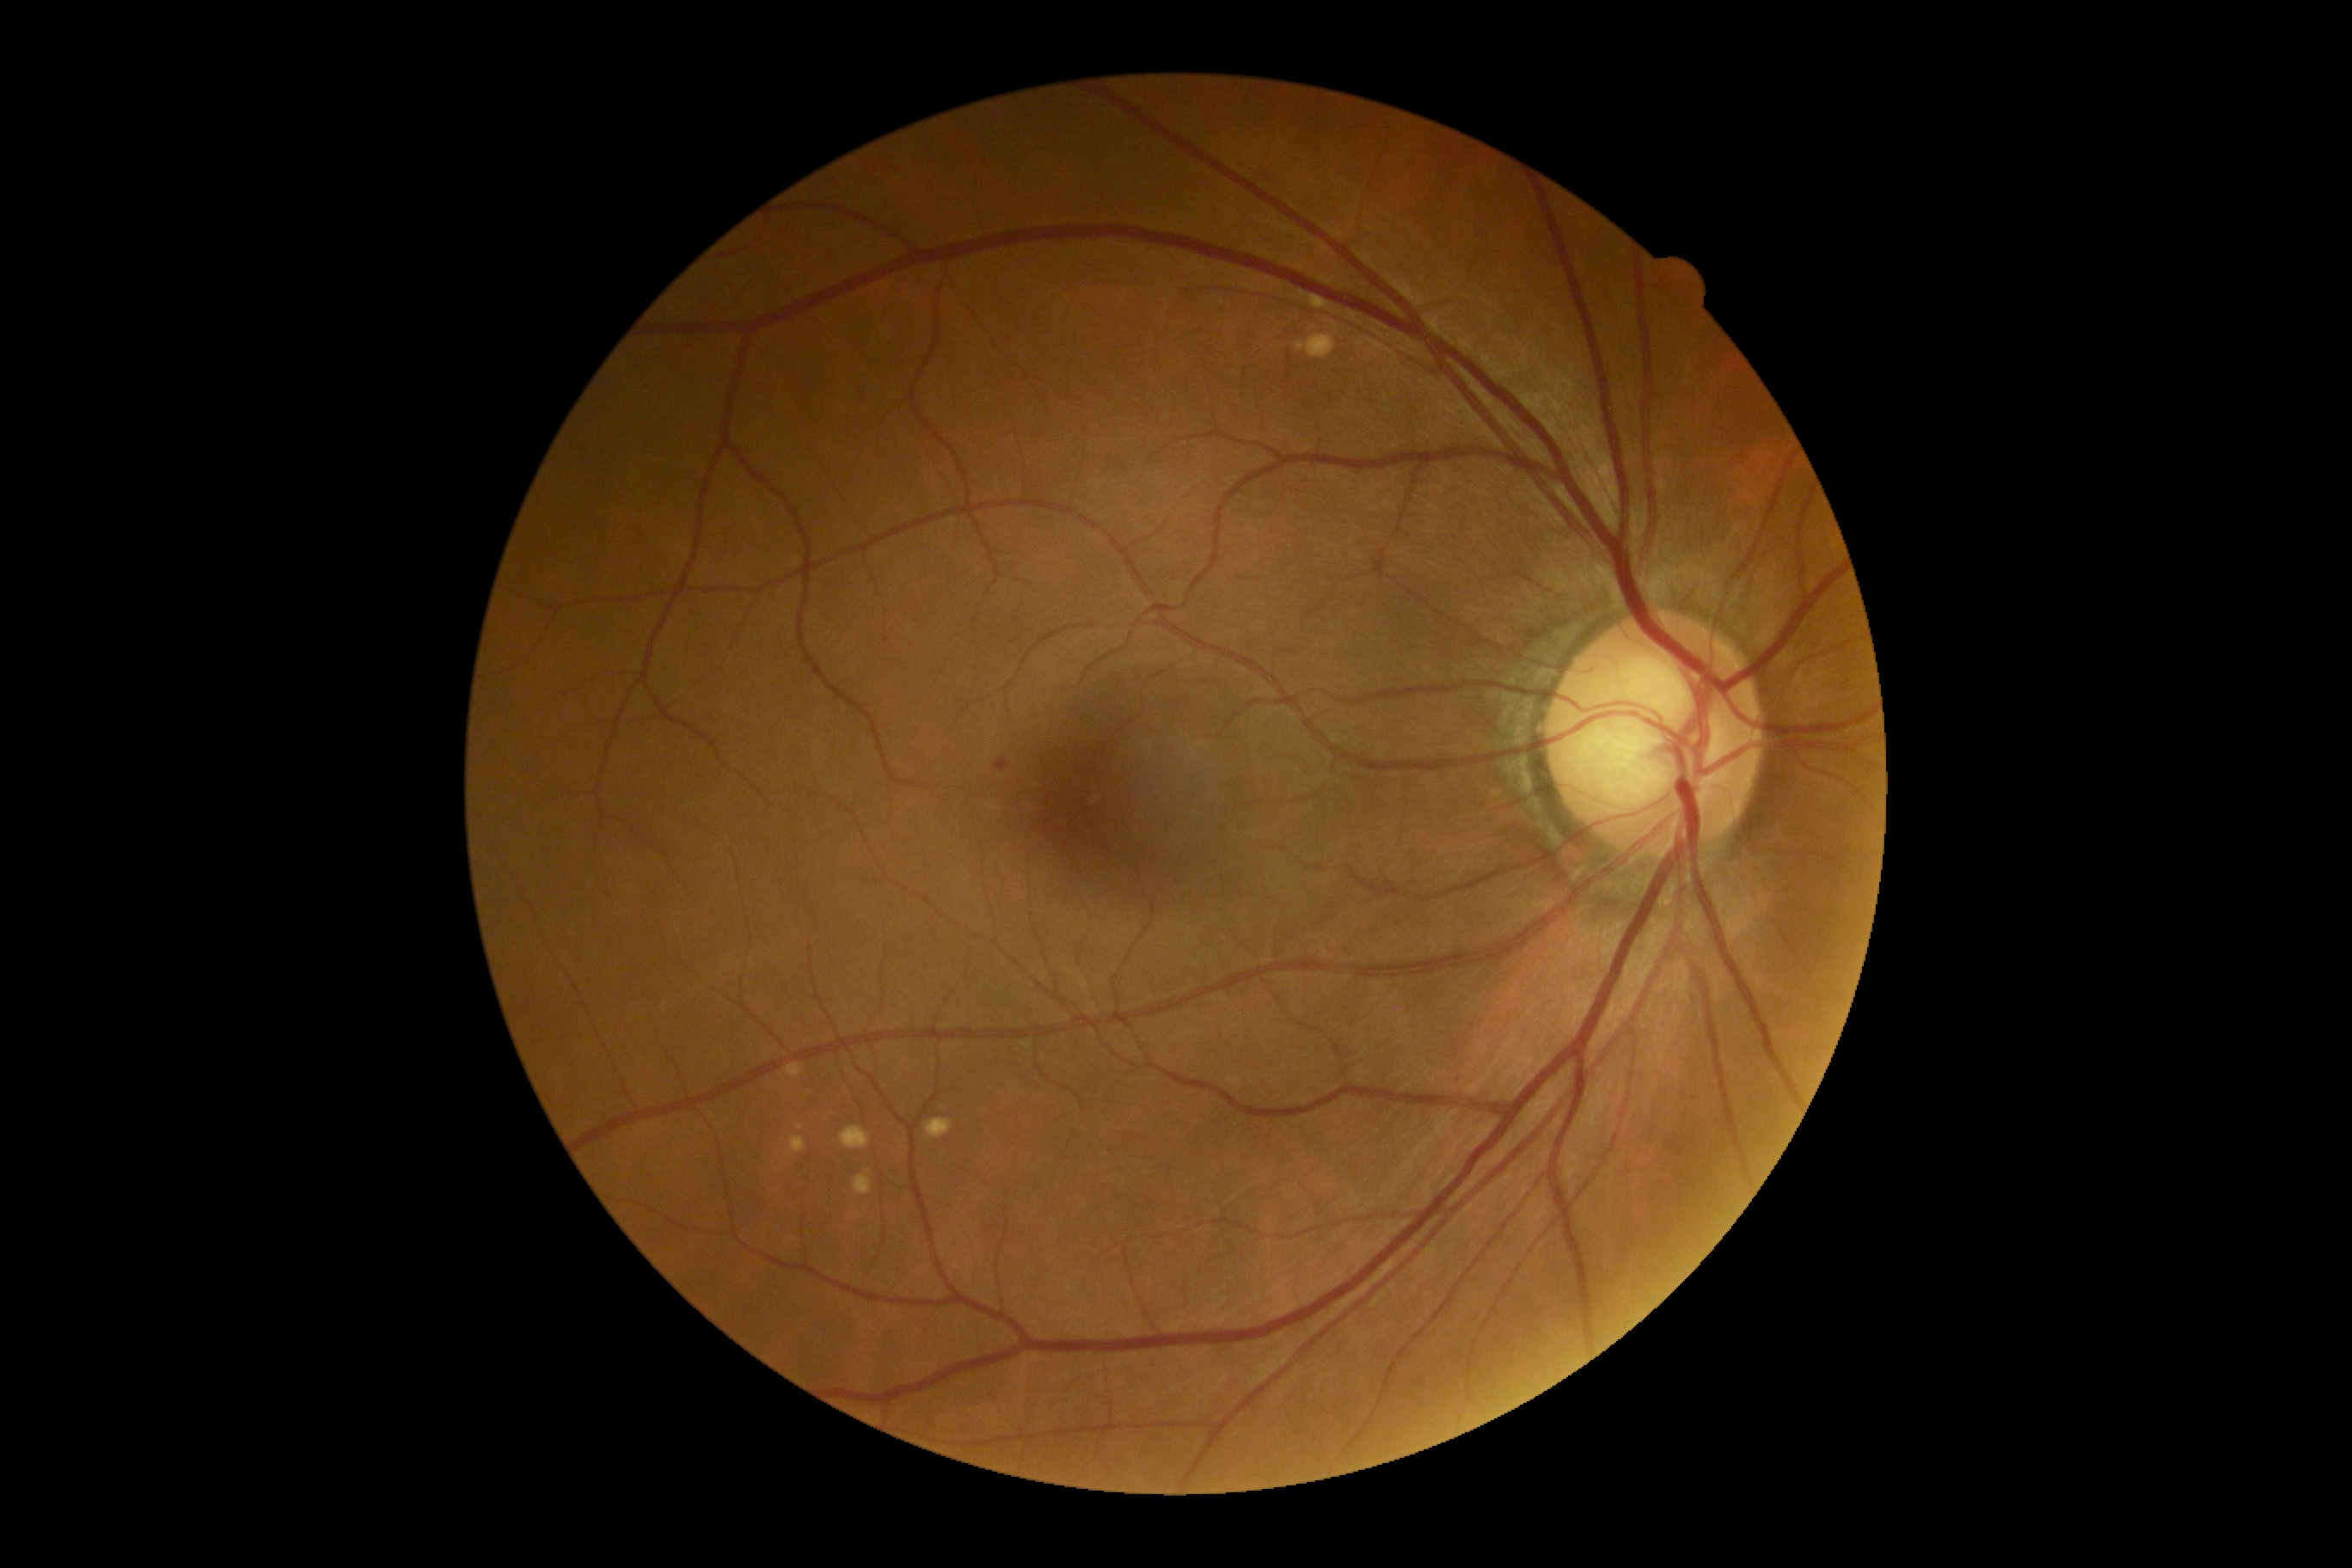 {
  "dr_grade": "2",
  "dr_category": "non-proliferative diabetic retinopathy"
}